Modified Davis classification, NIDEK AFC-230
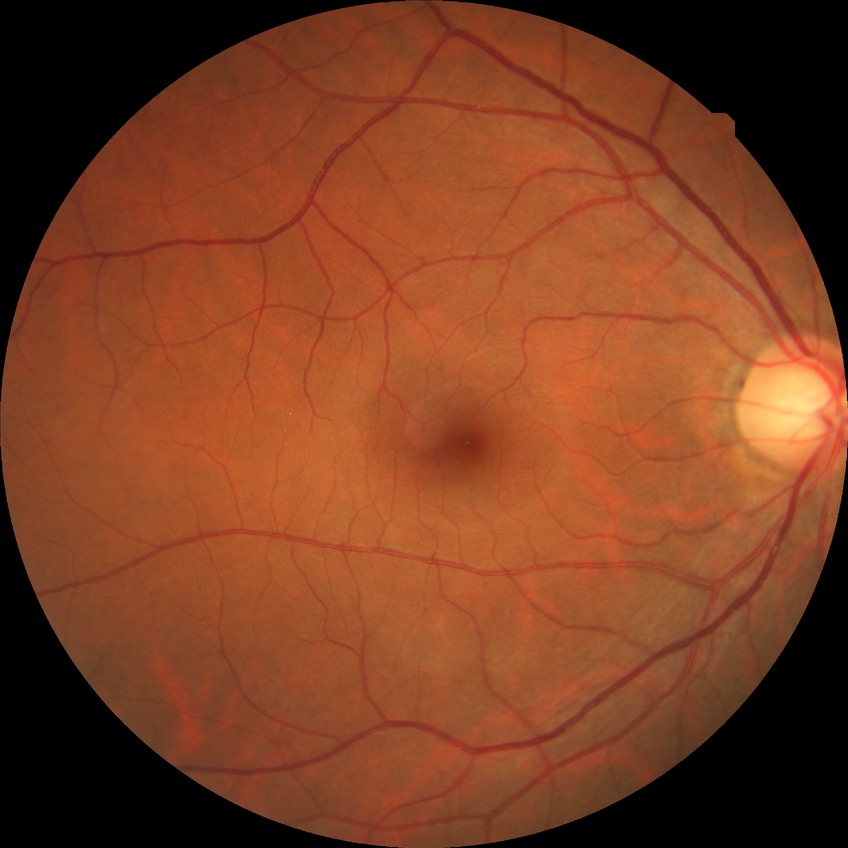

DR grade = NDR.